1240 by 1240 pixels · Phoenix ICON wide-field infant fundus image:
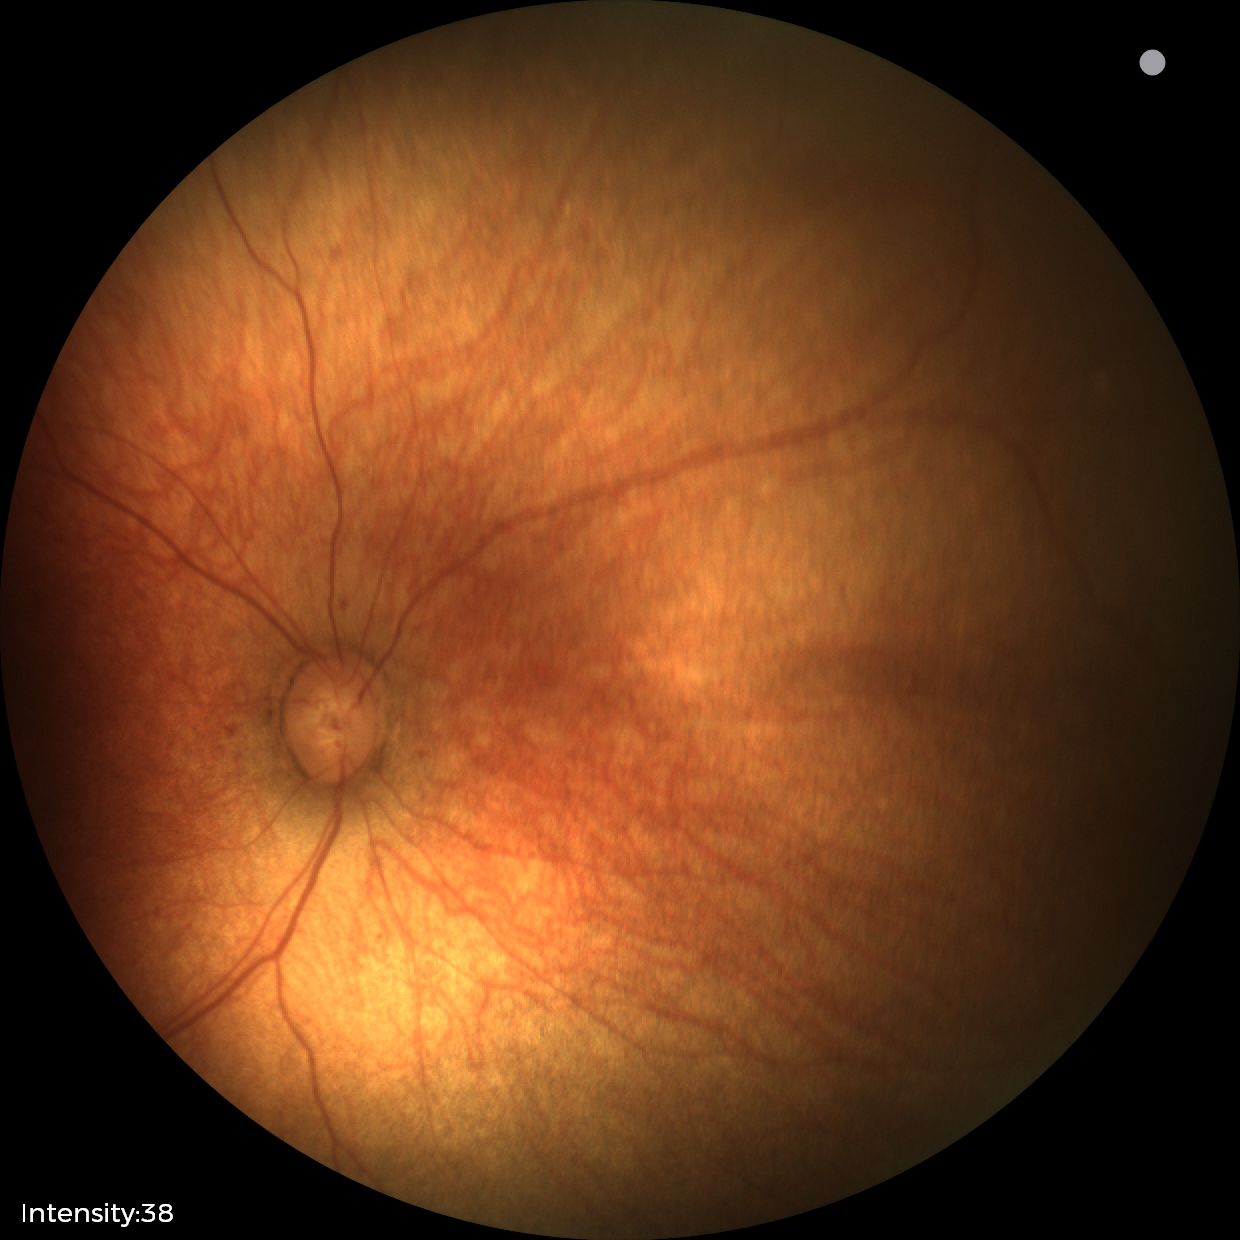 No retinal pathology identified on screening.